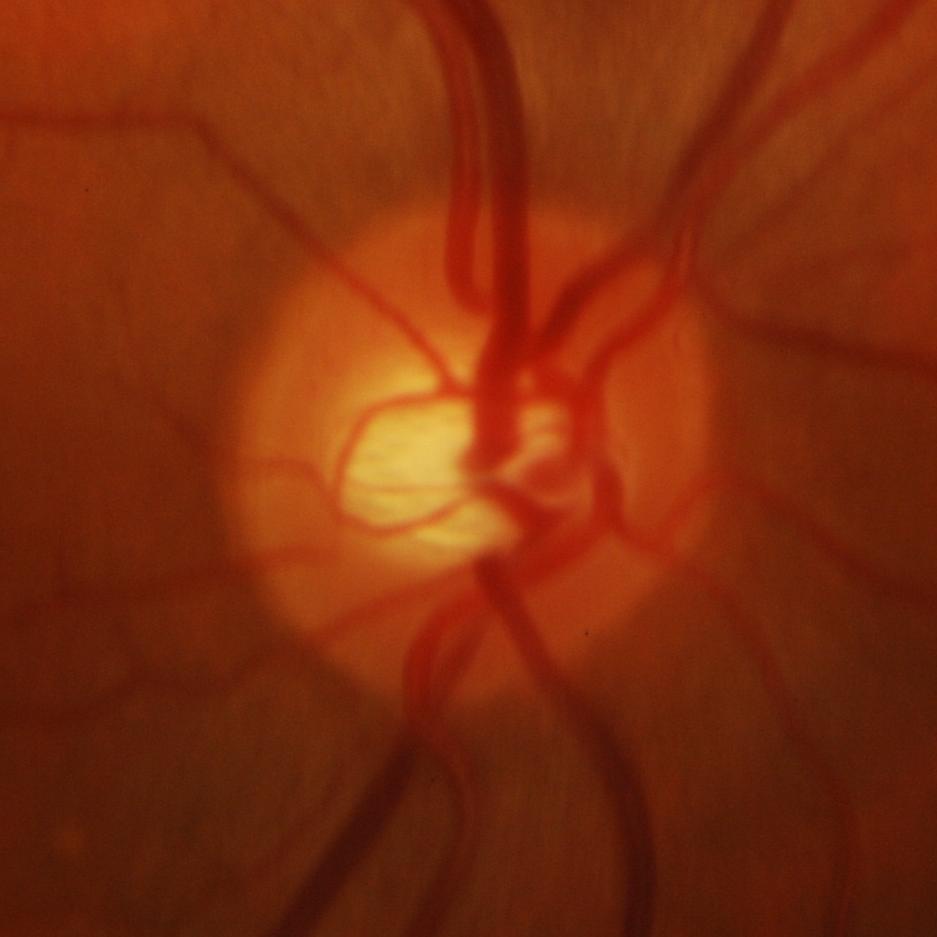 Q: Does this eye have glaucoma?
A: Yes — glaucoma.